45-degree field of view, posterior pole photograph.
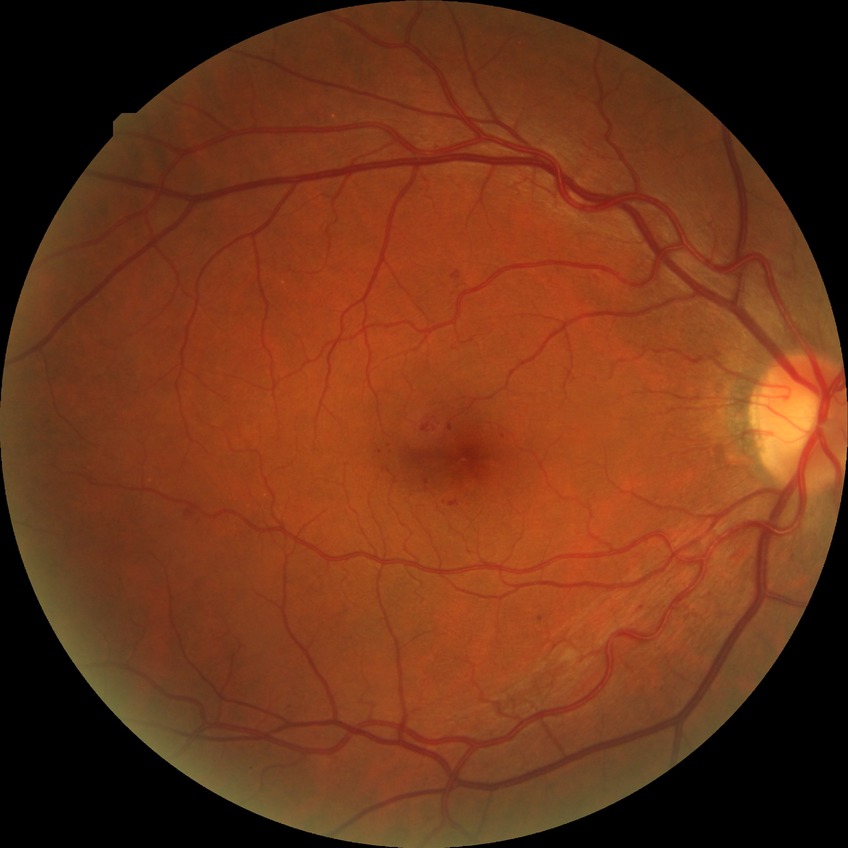

retinopathy stage=simple diabetic retinopathy.